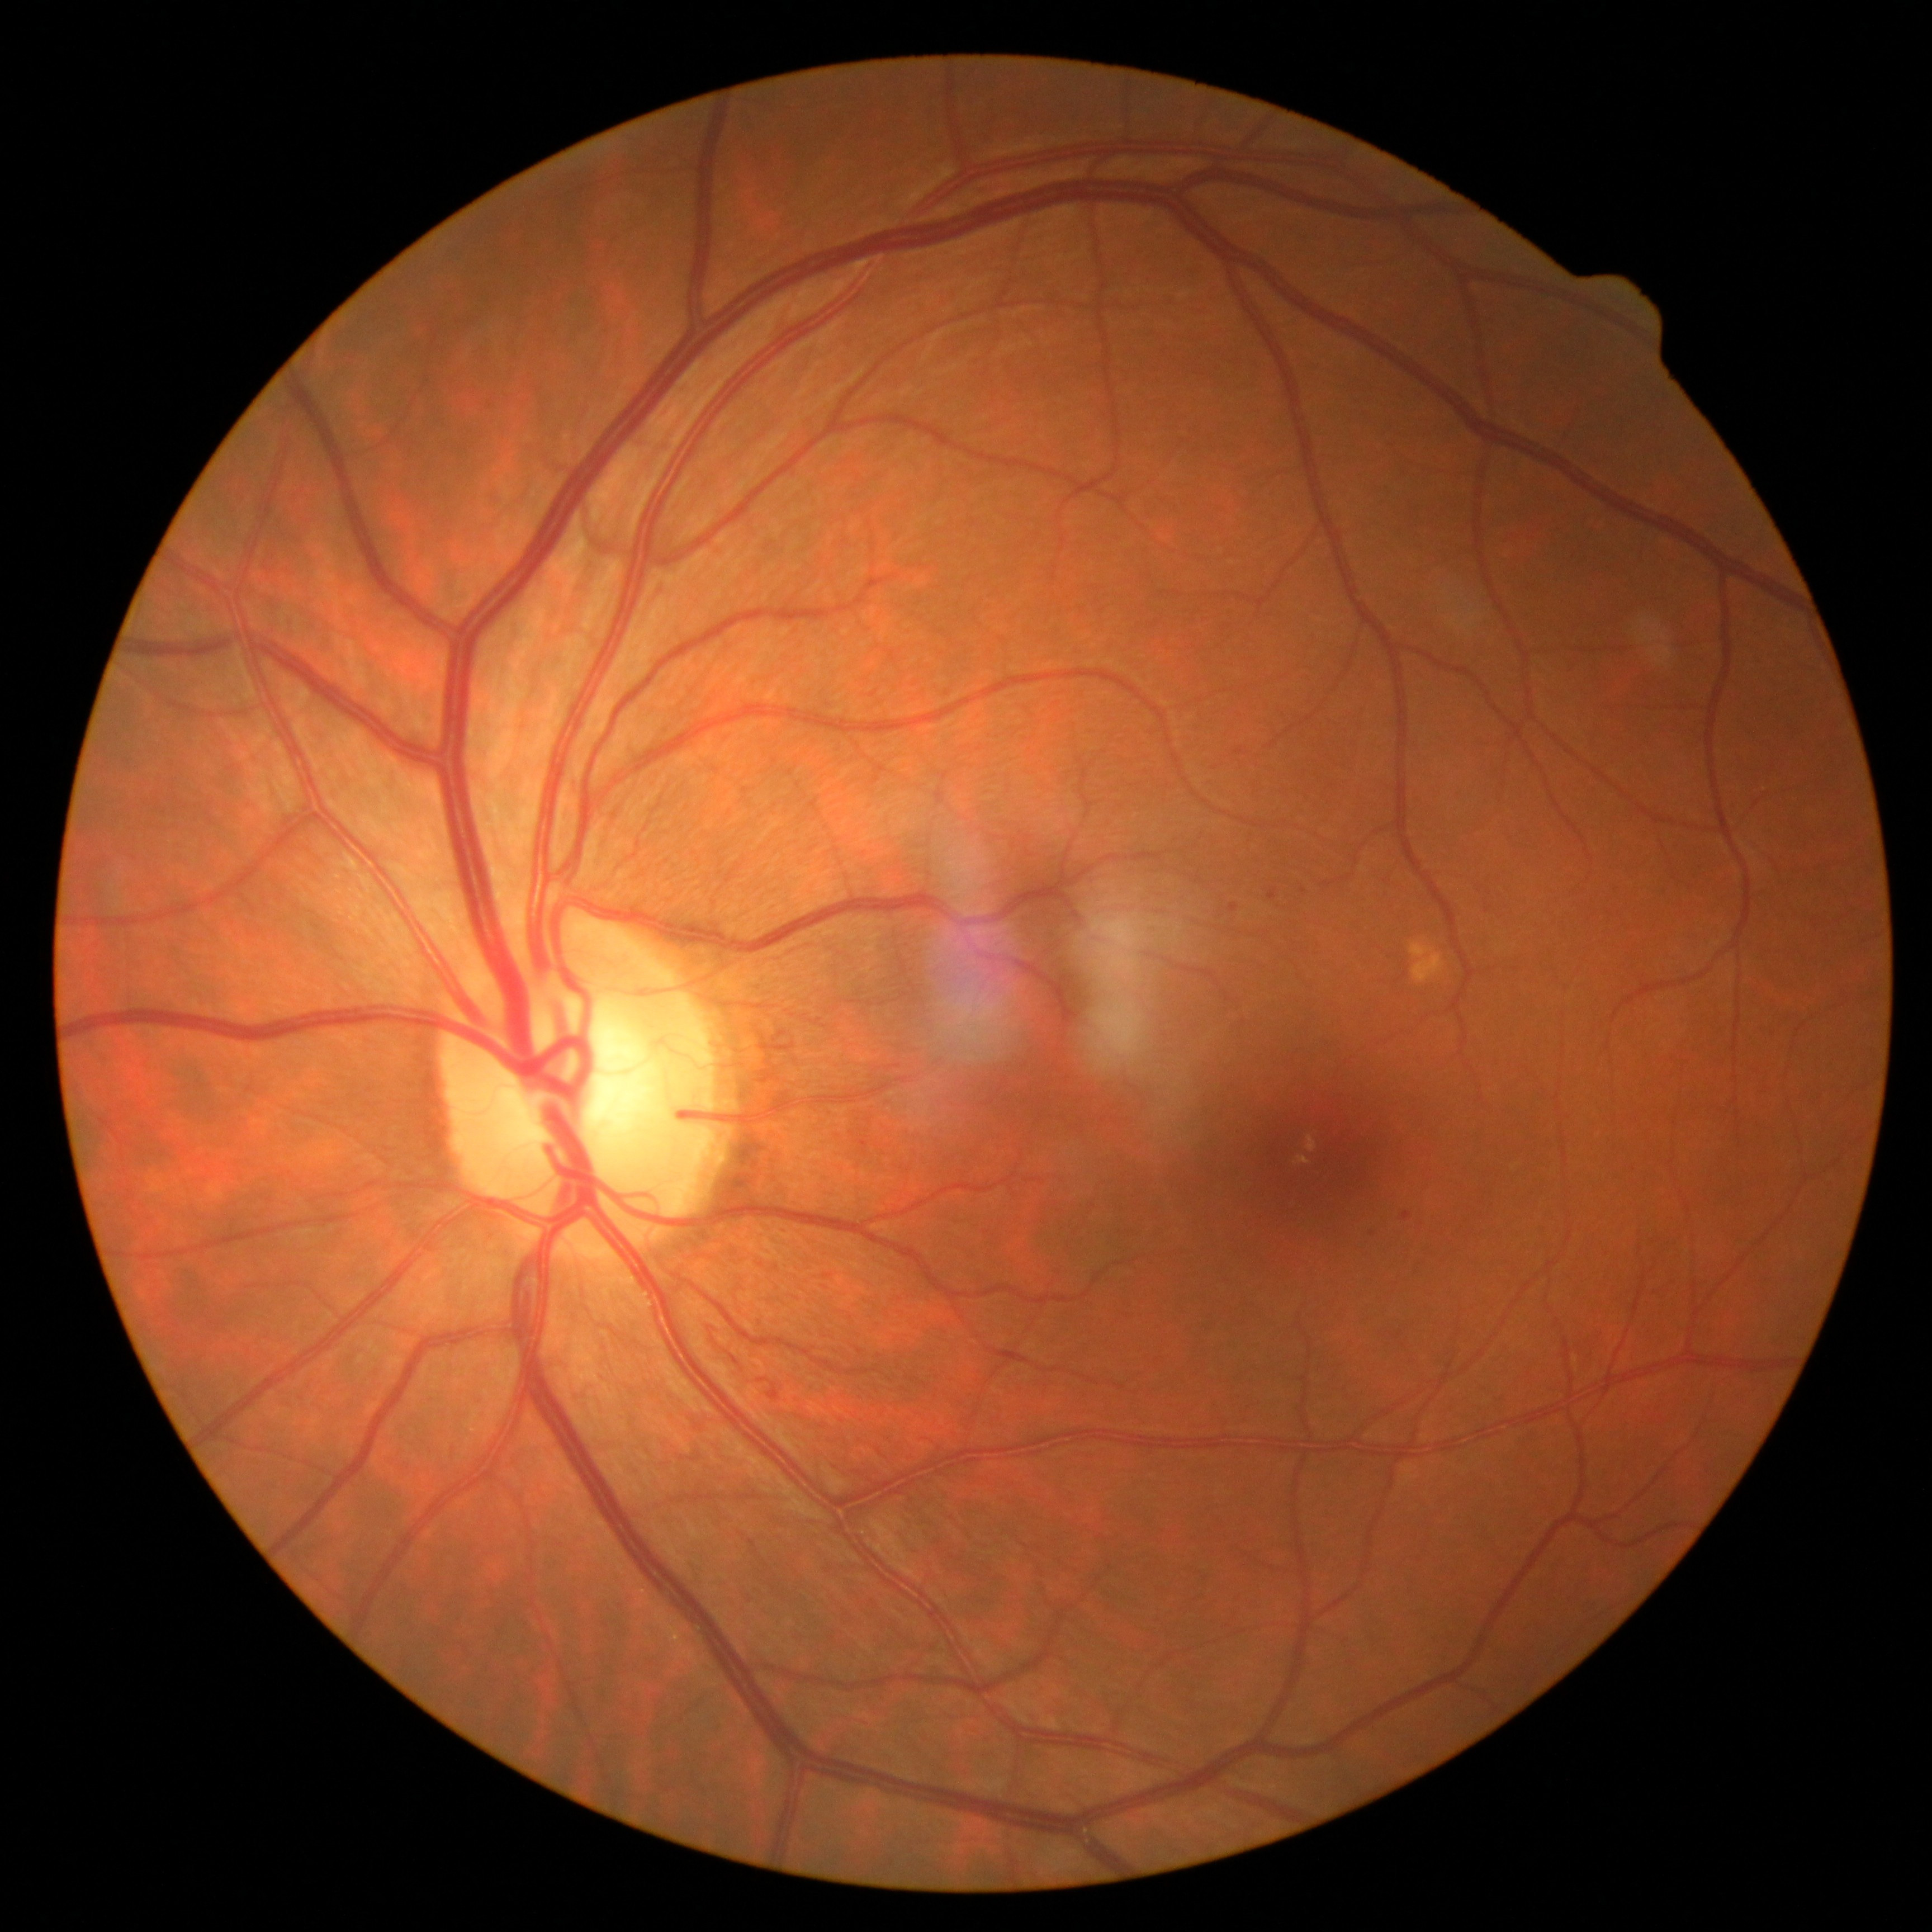
Diabetic retinopathy is 1/4.